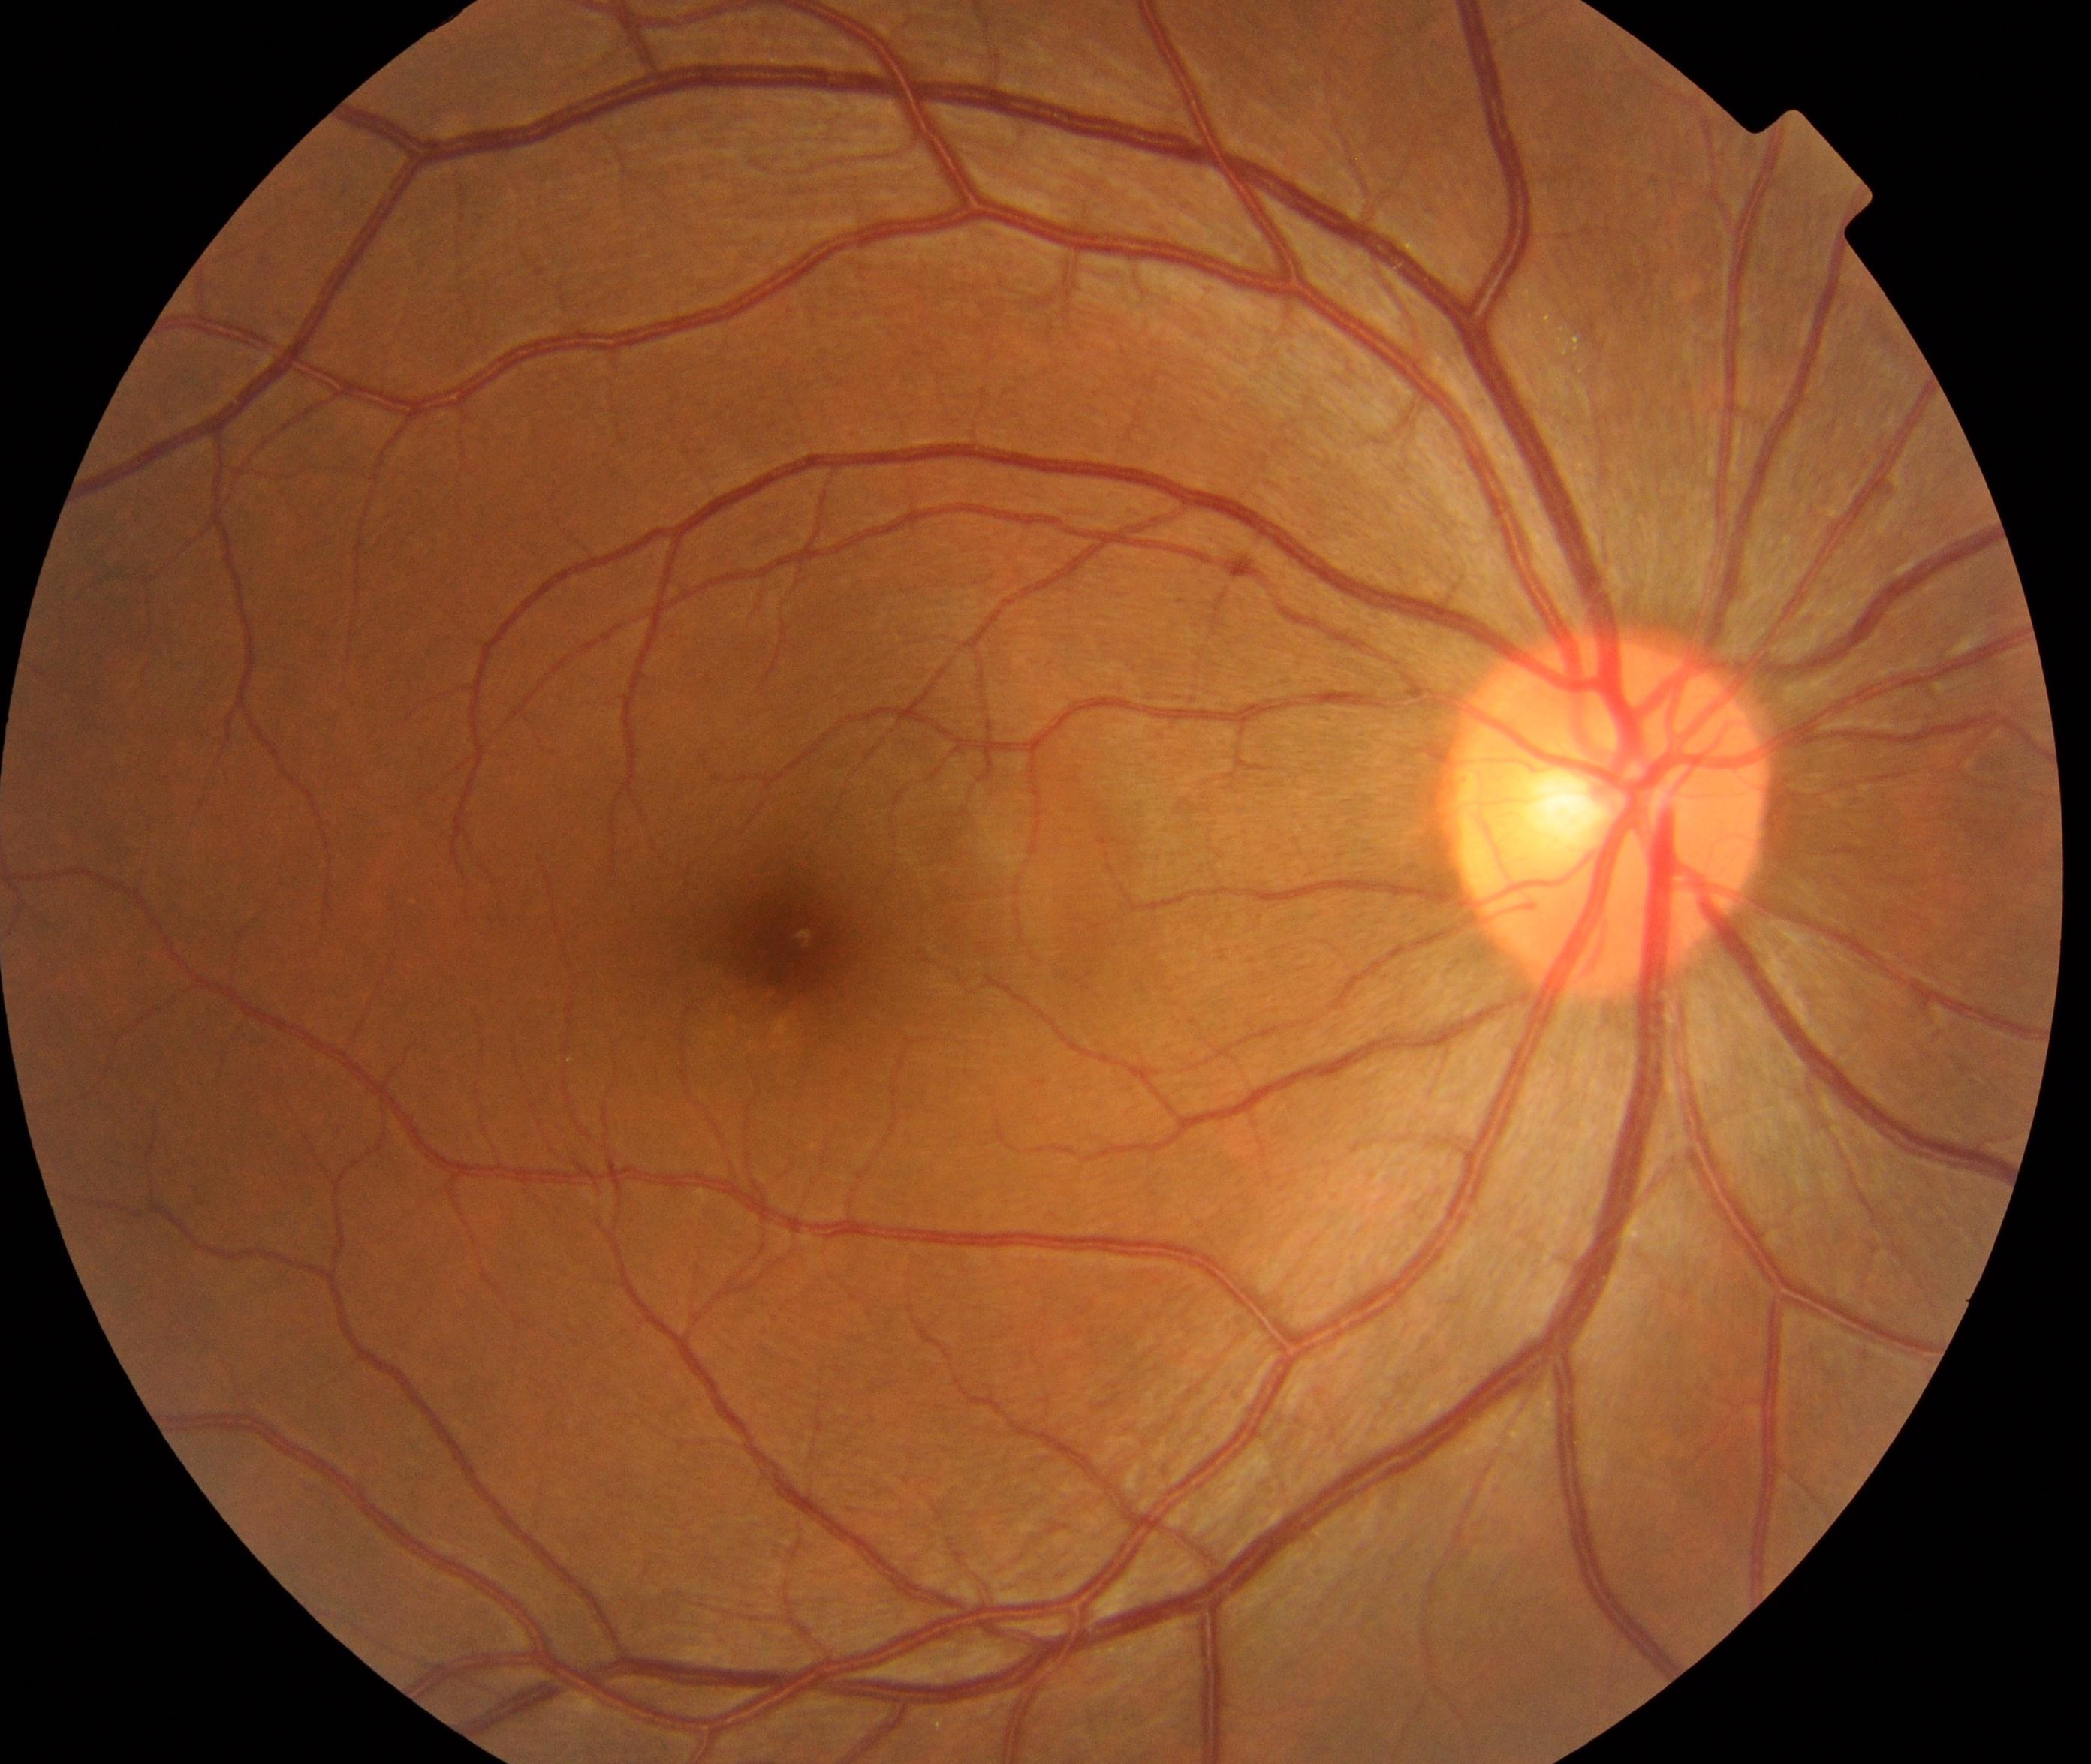

No retinal pathology identified.